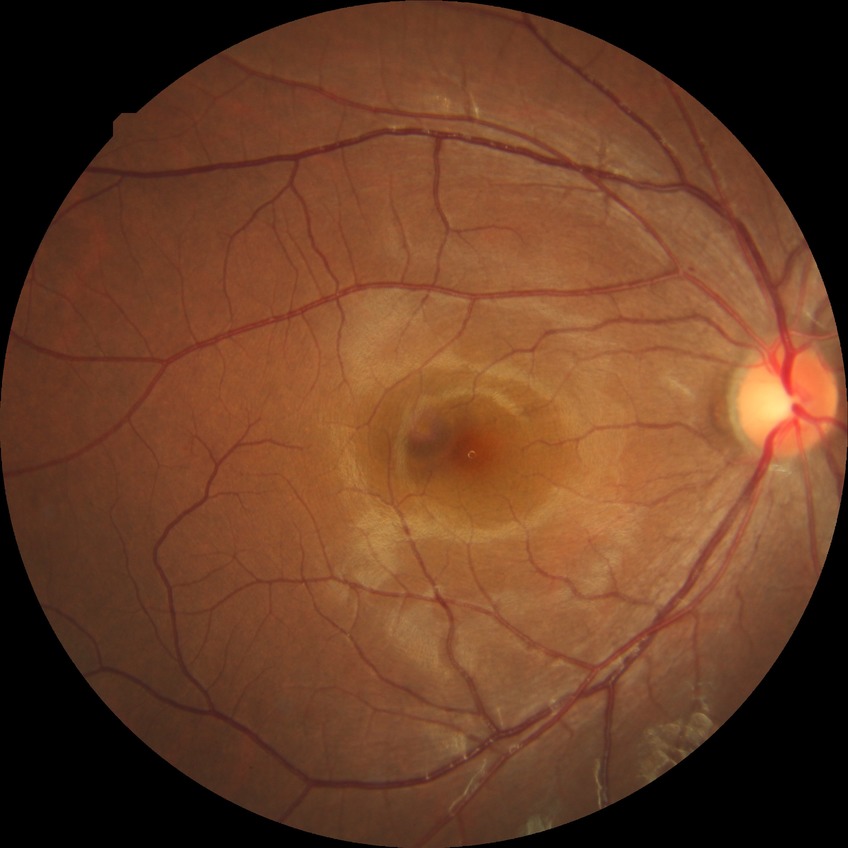 Diabetic retinopathy grade: no diabetic retinopathy.